60-degree field of view · 2212x1659px:
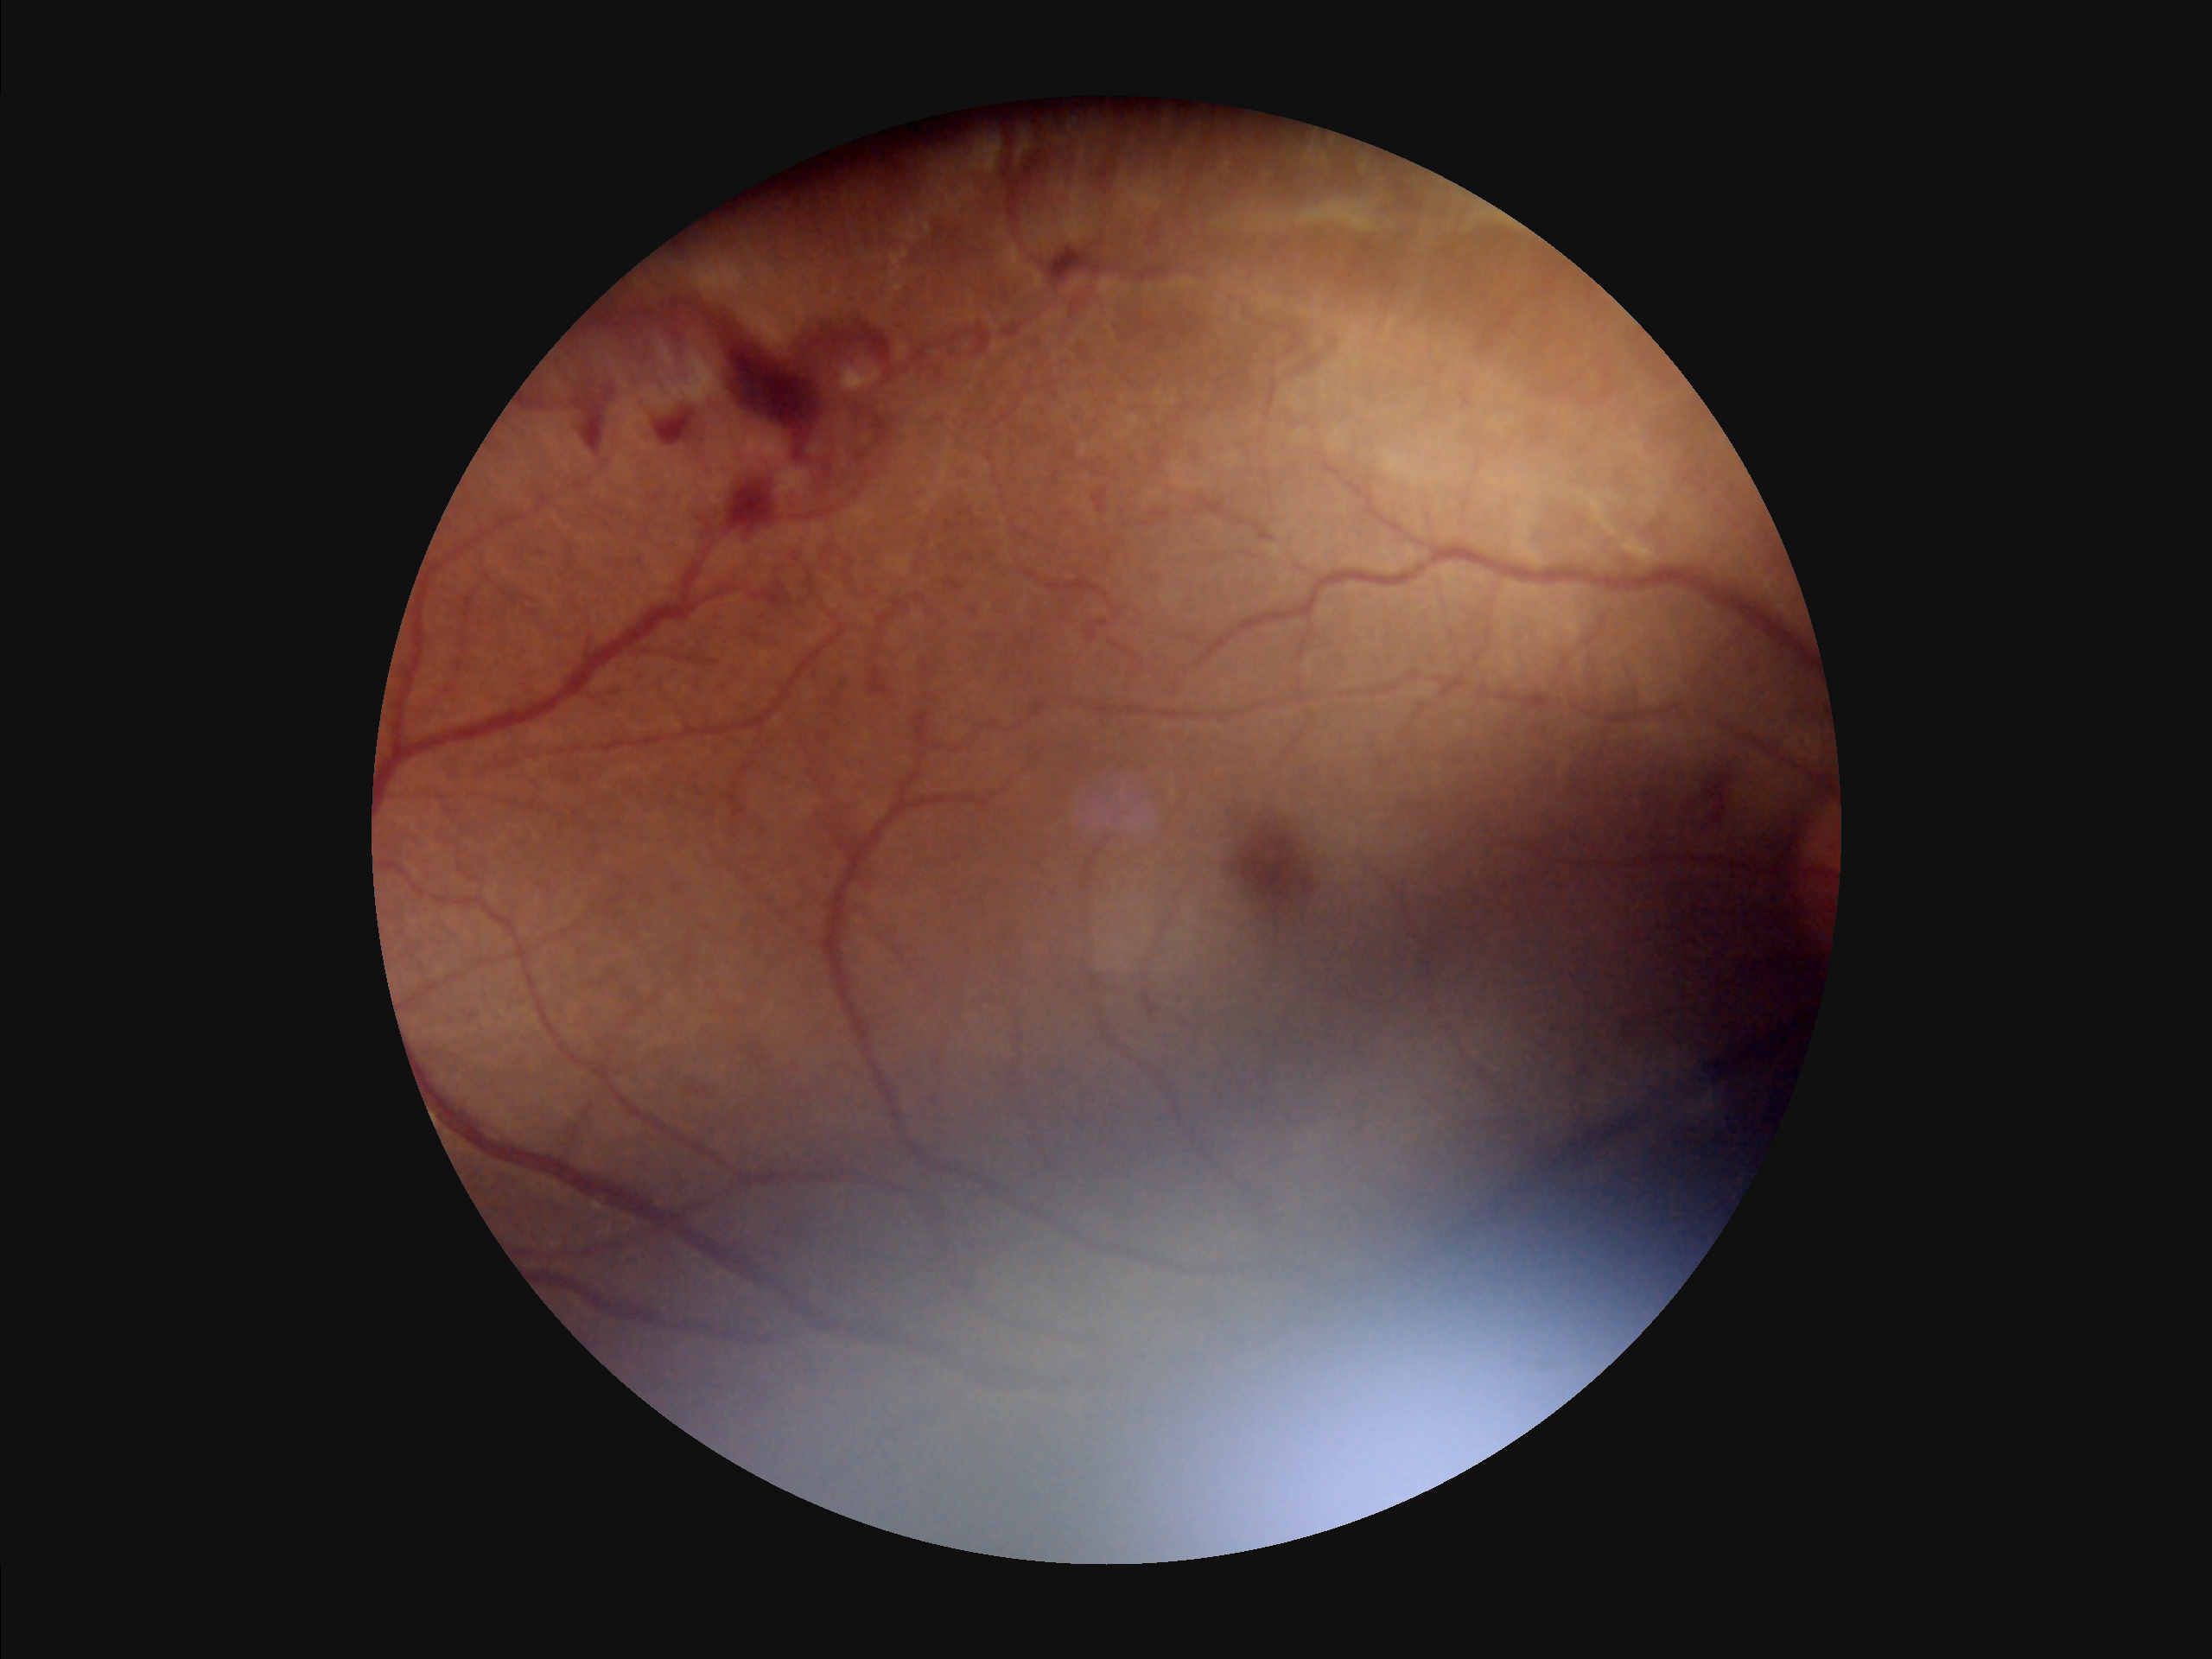

Contrast = poor; Overall = low; Clarity = reduced; Illumination/color = suboptimal.